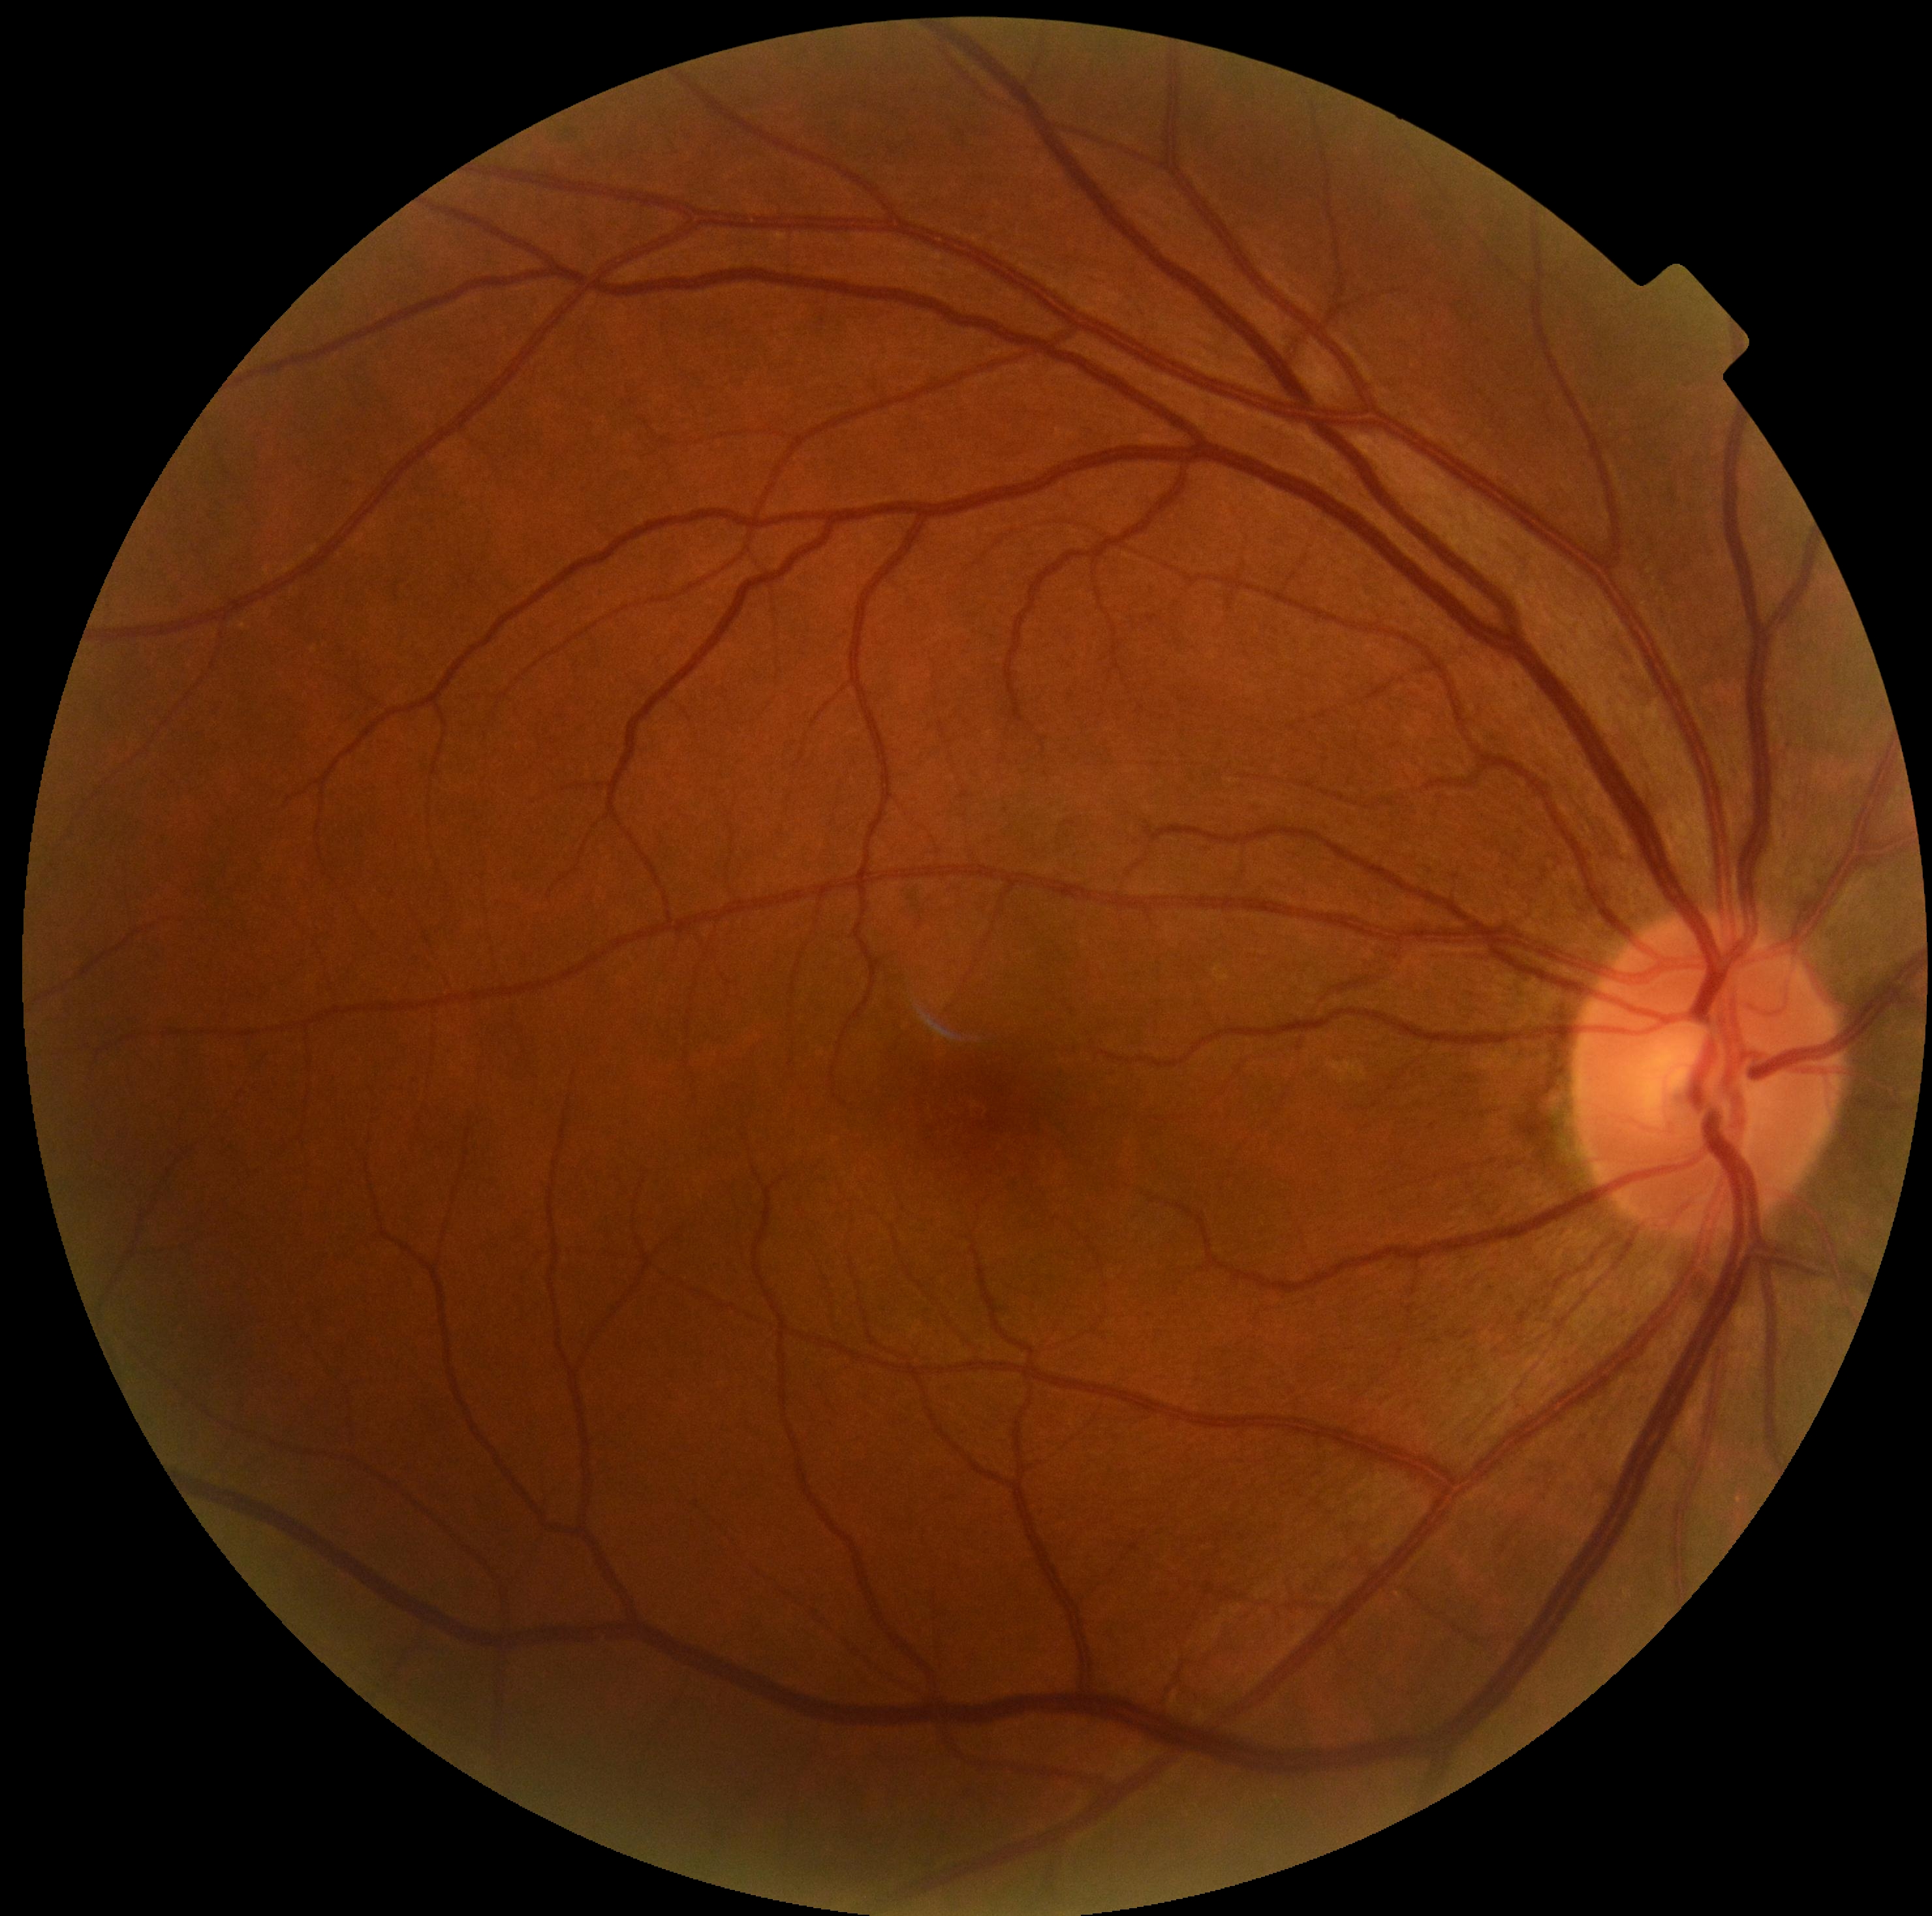
Annotations:
– diabetic retinopathy (DR) — grade 0